FOV: 45 degrees: 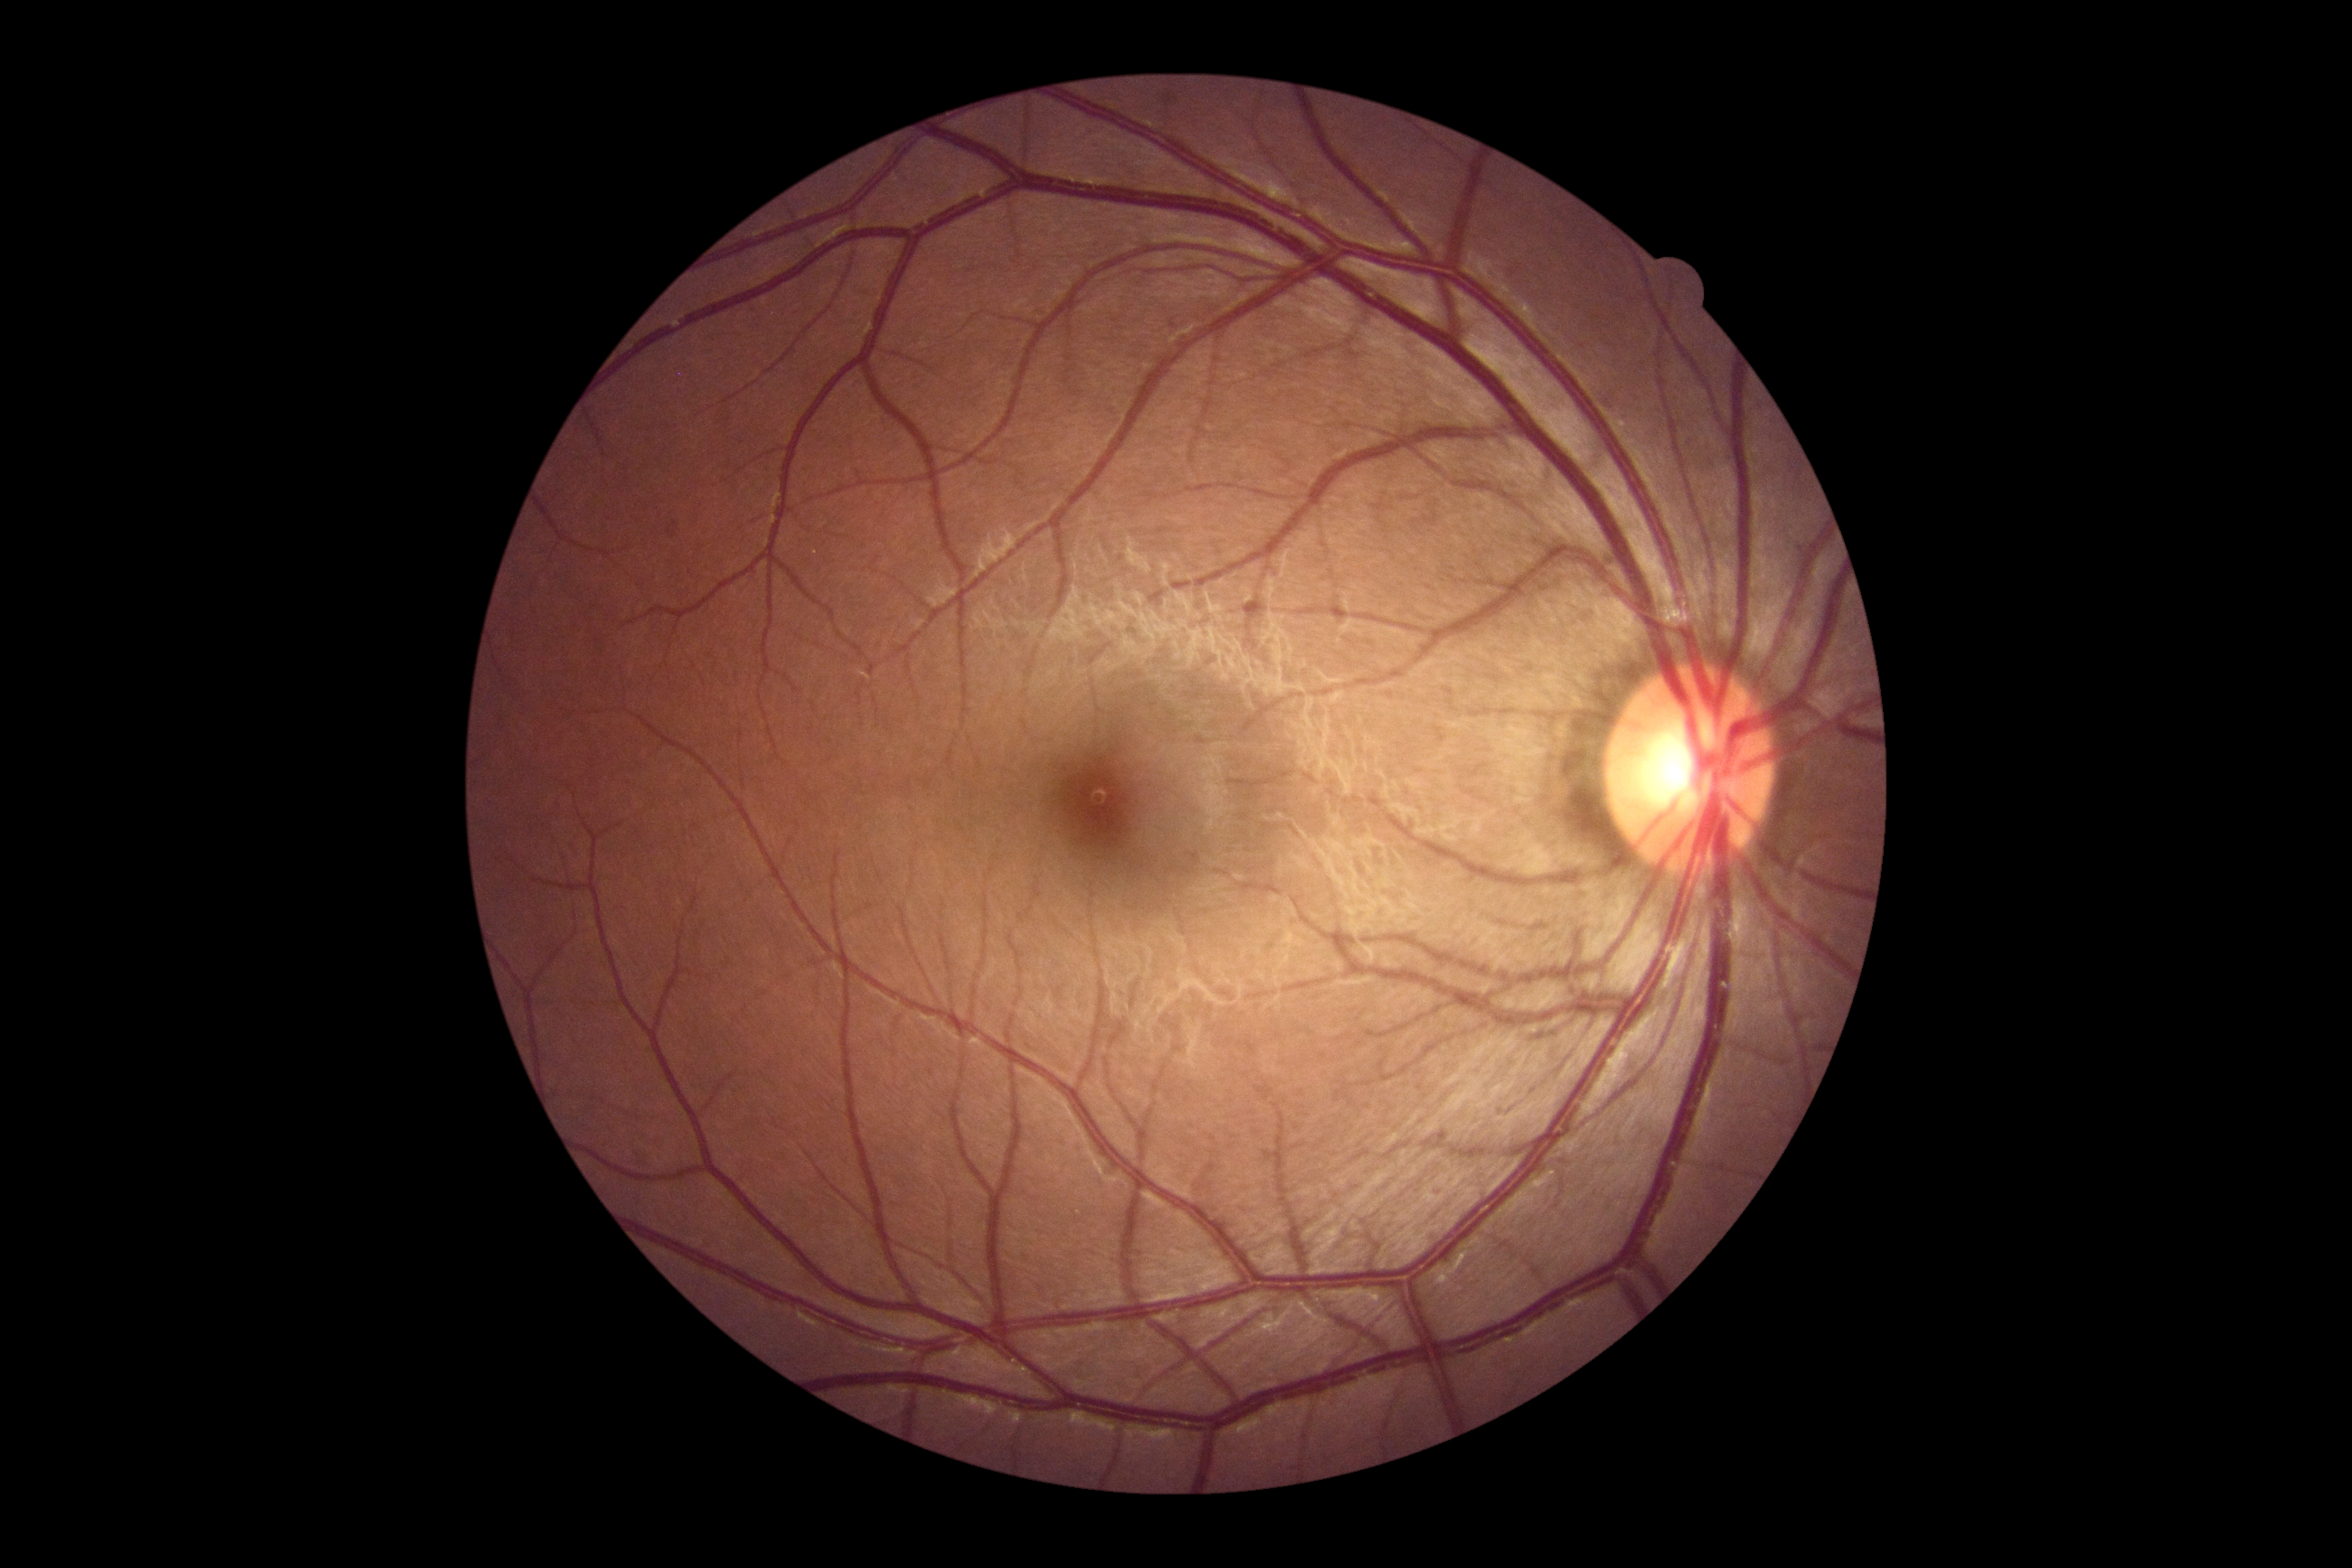
DR severity: no apparent diabetic retinopathy (grade 0) — no visible signs of diabetic retinopathy.